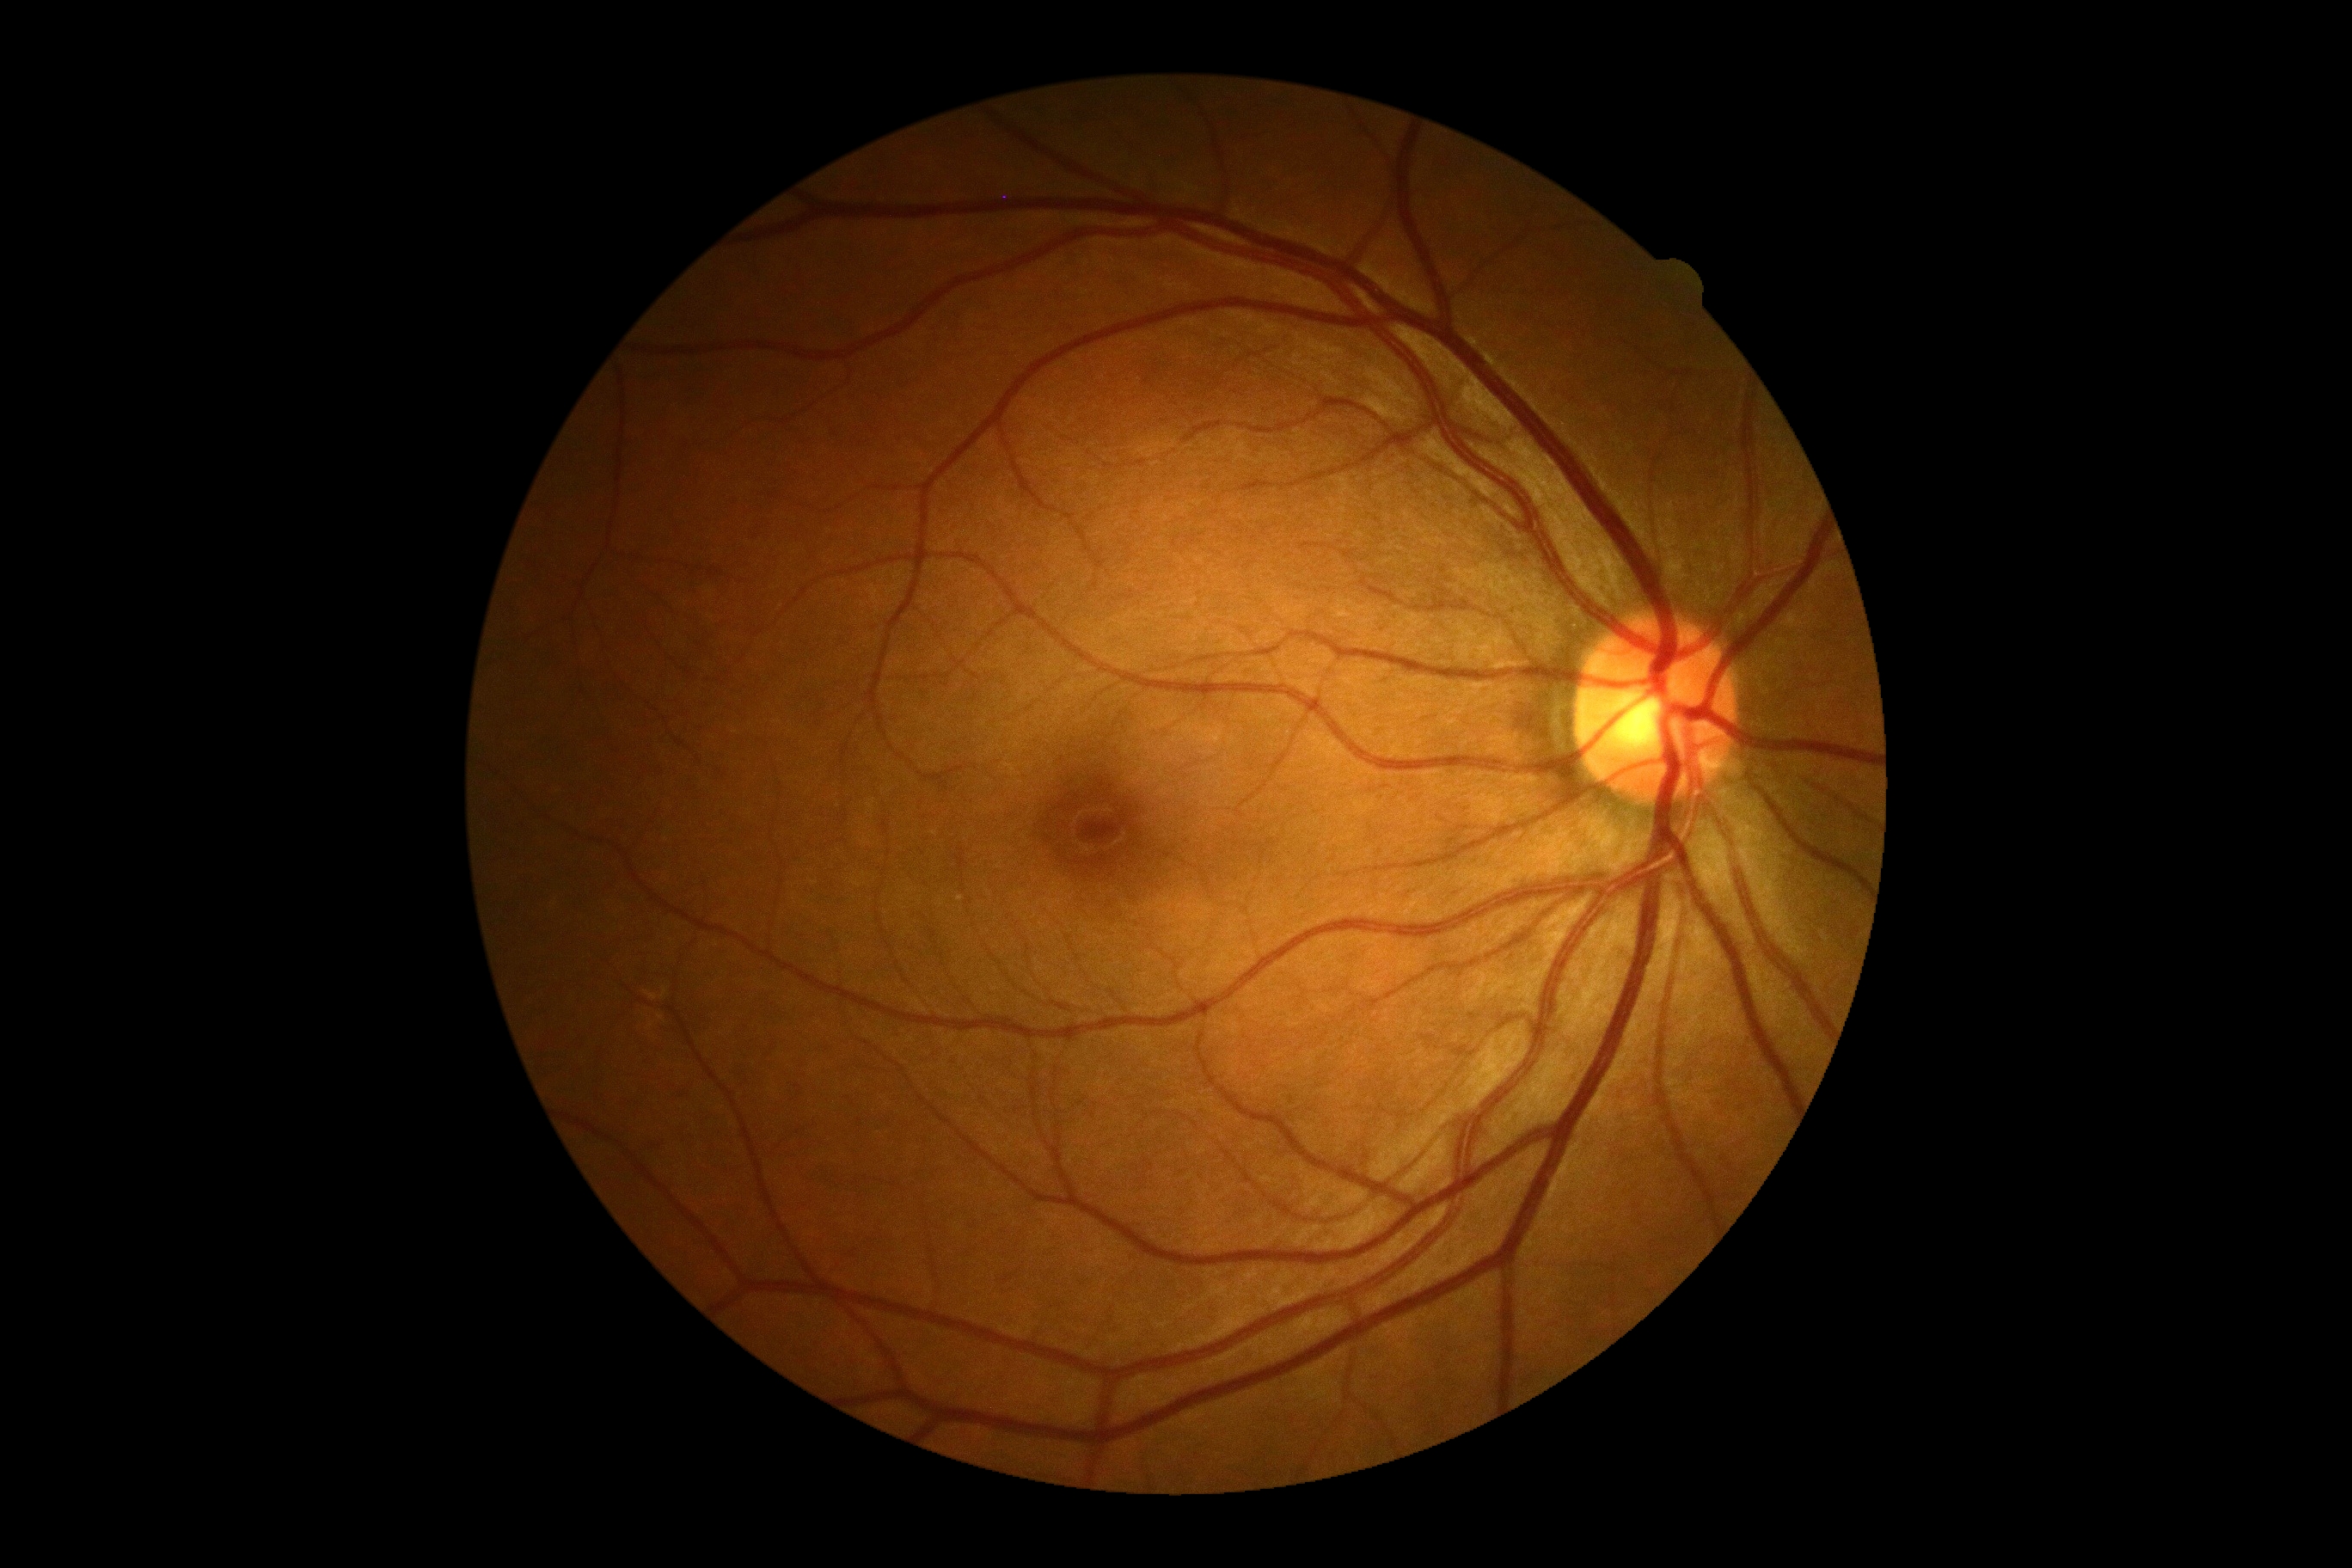 Diabetic retinopathy severity: grade 0.